Fundus photo · 2212 x 1659 pixels:
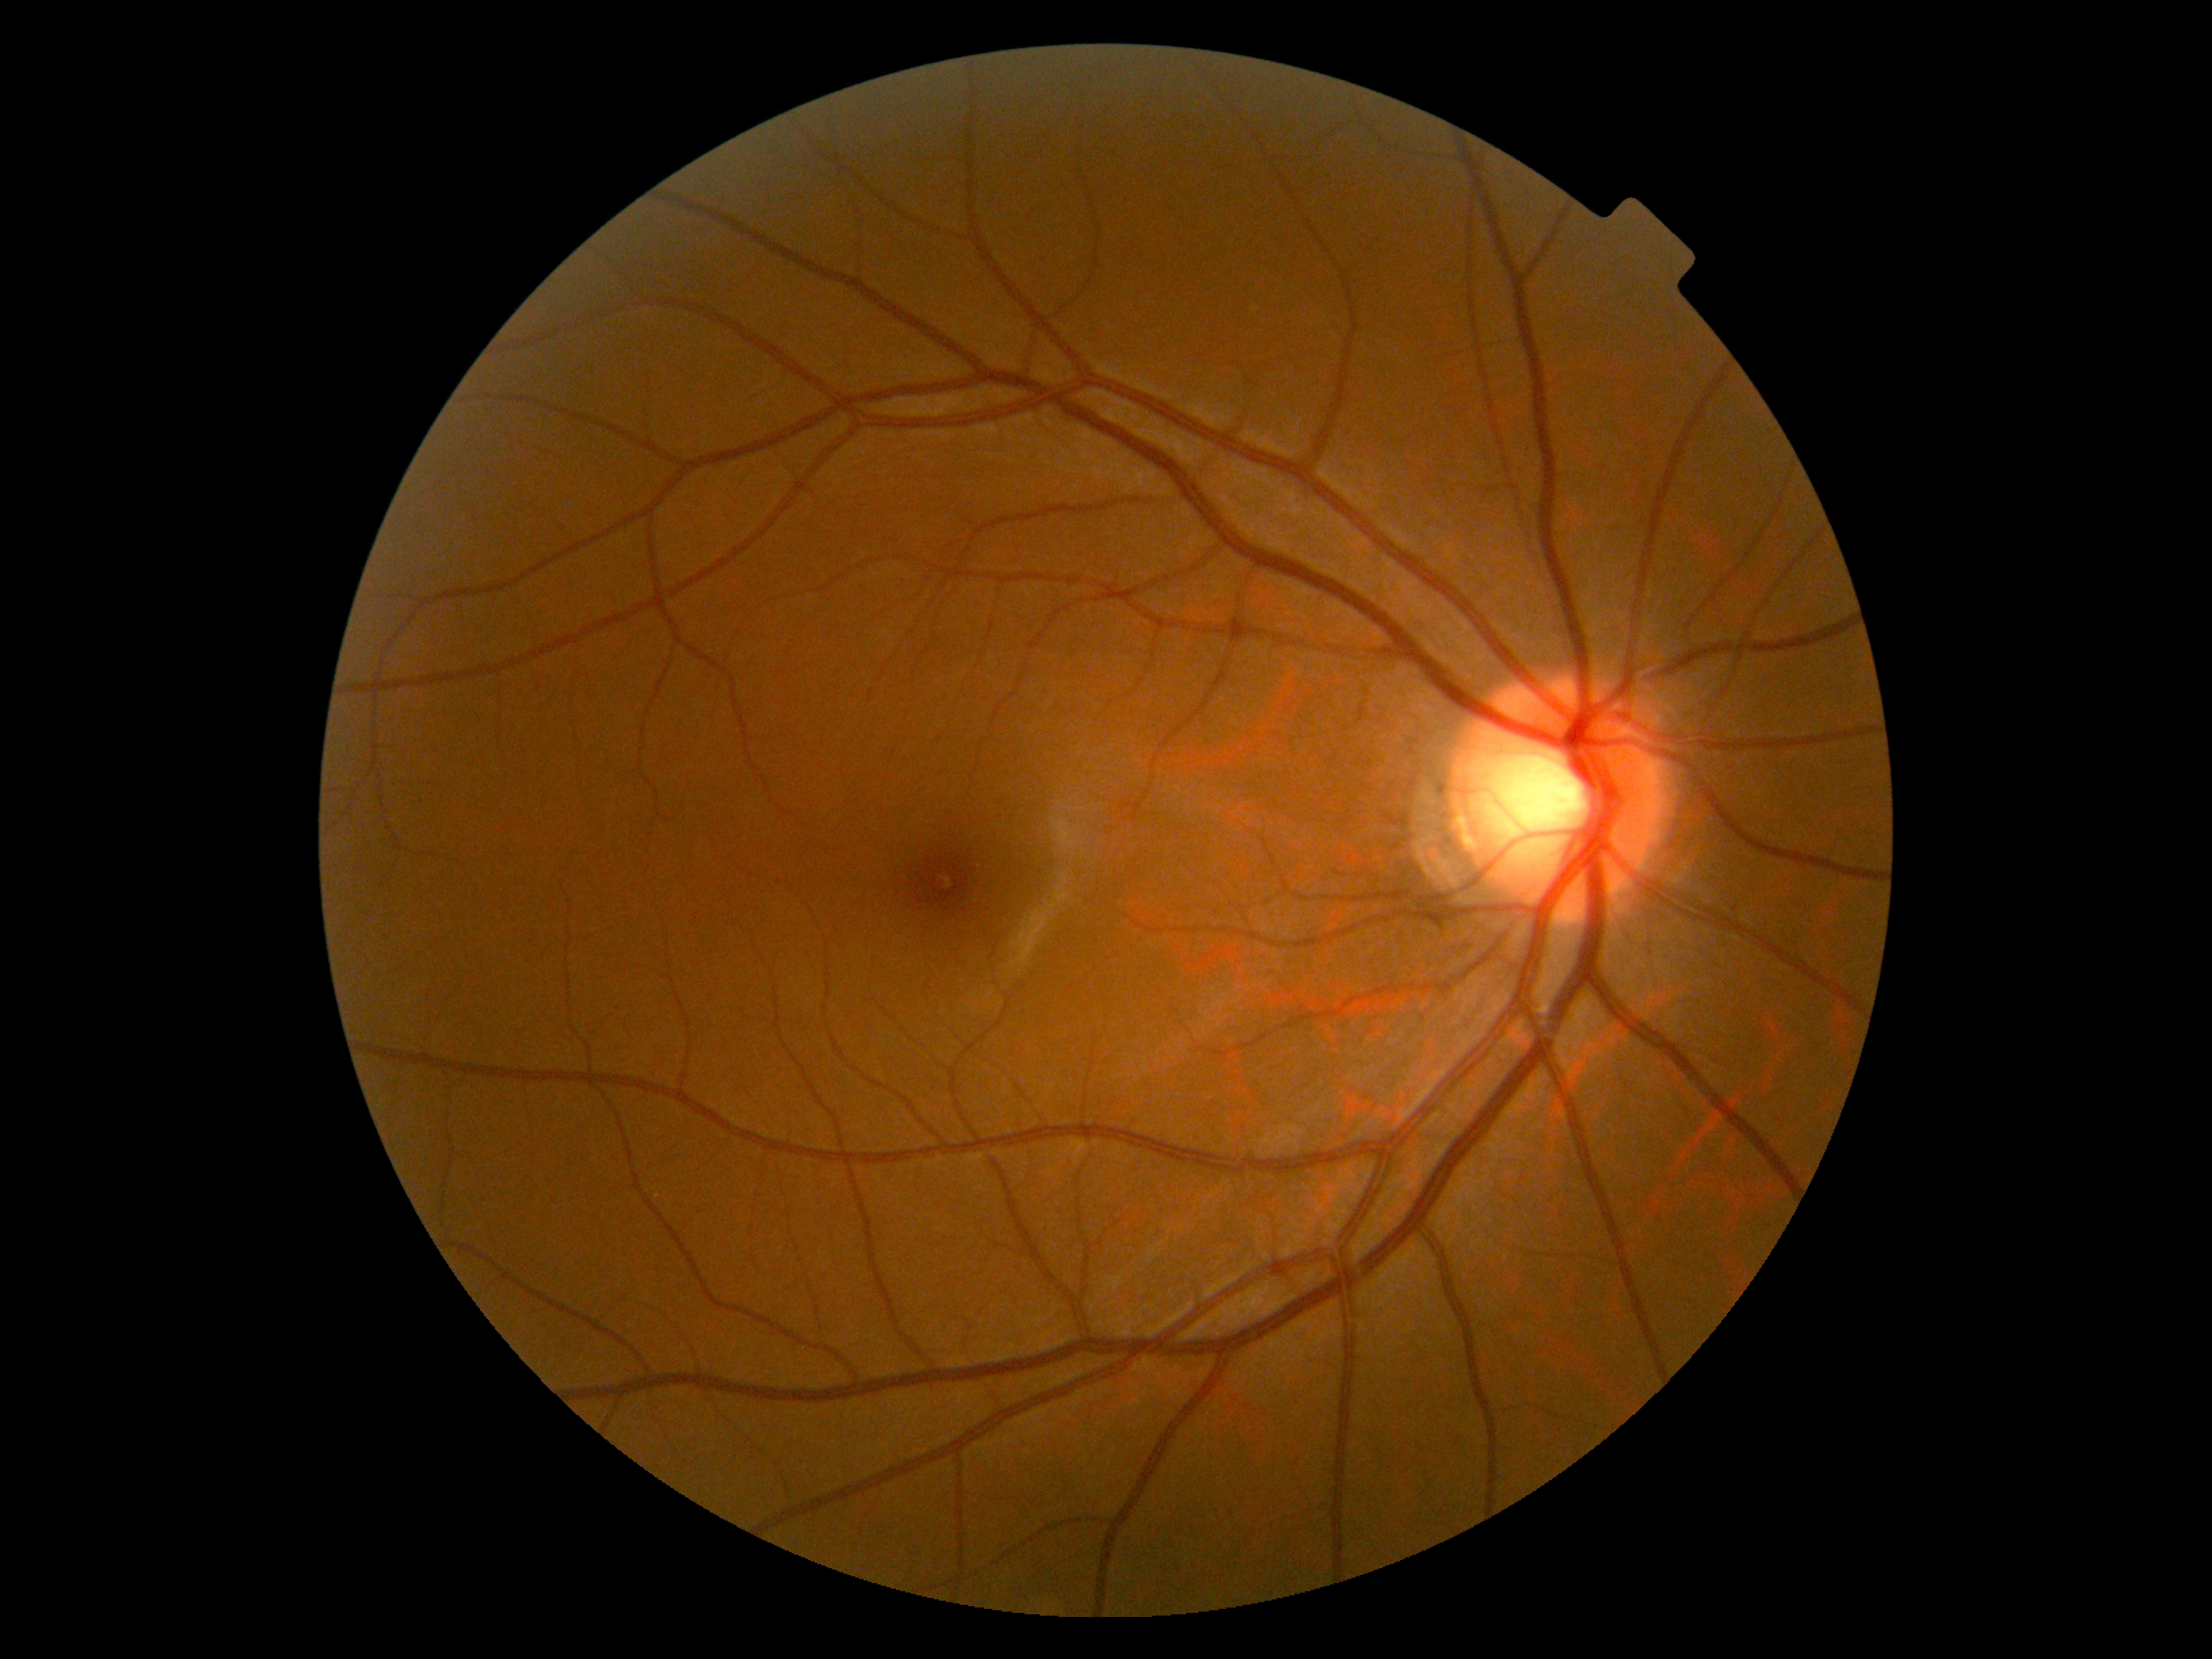

DR severity: no apparent diabetic retinopathy (grade 0).